1924x1556px, 200-degree field of view — 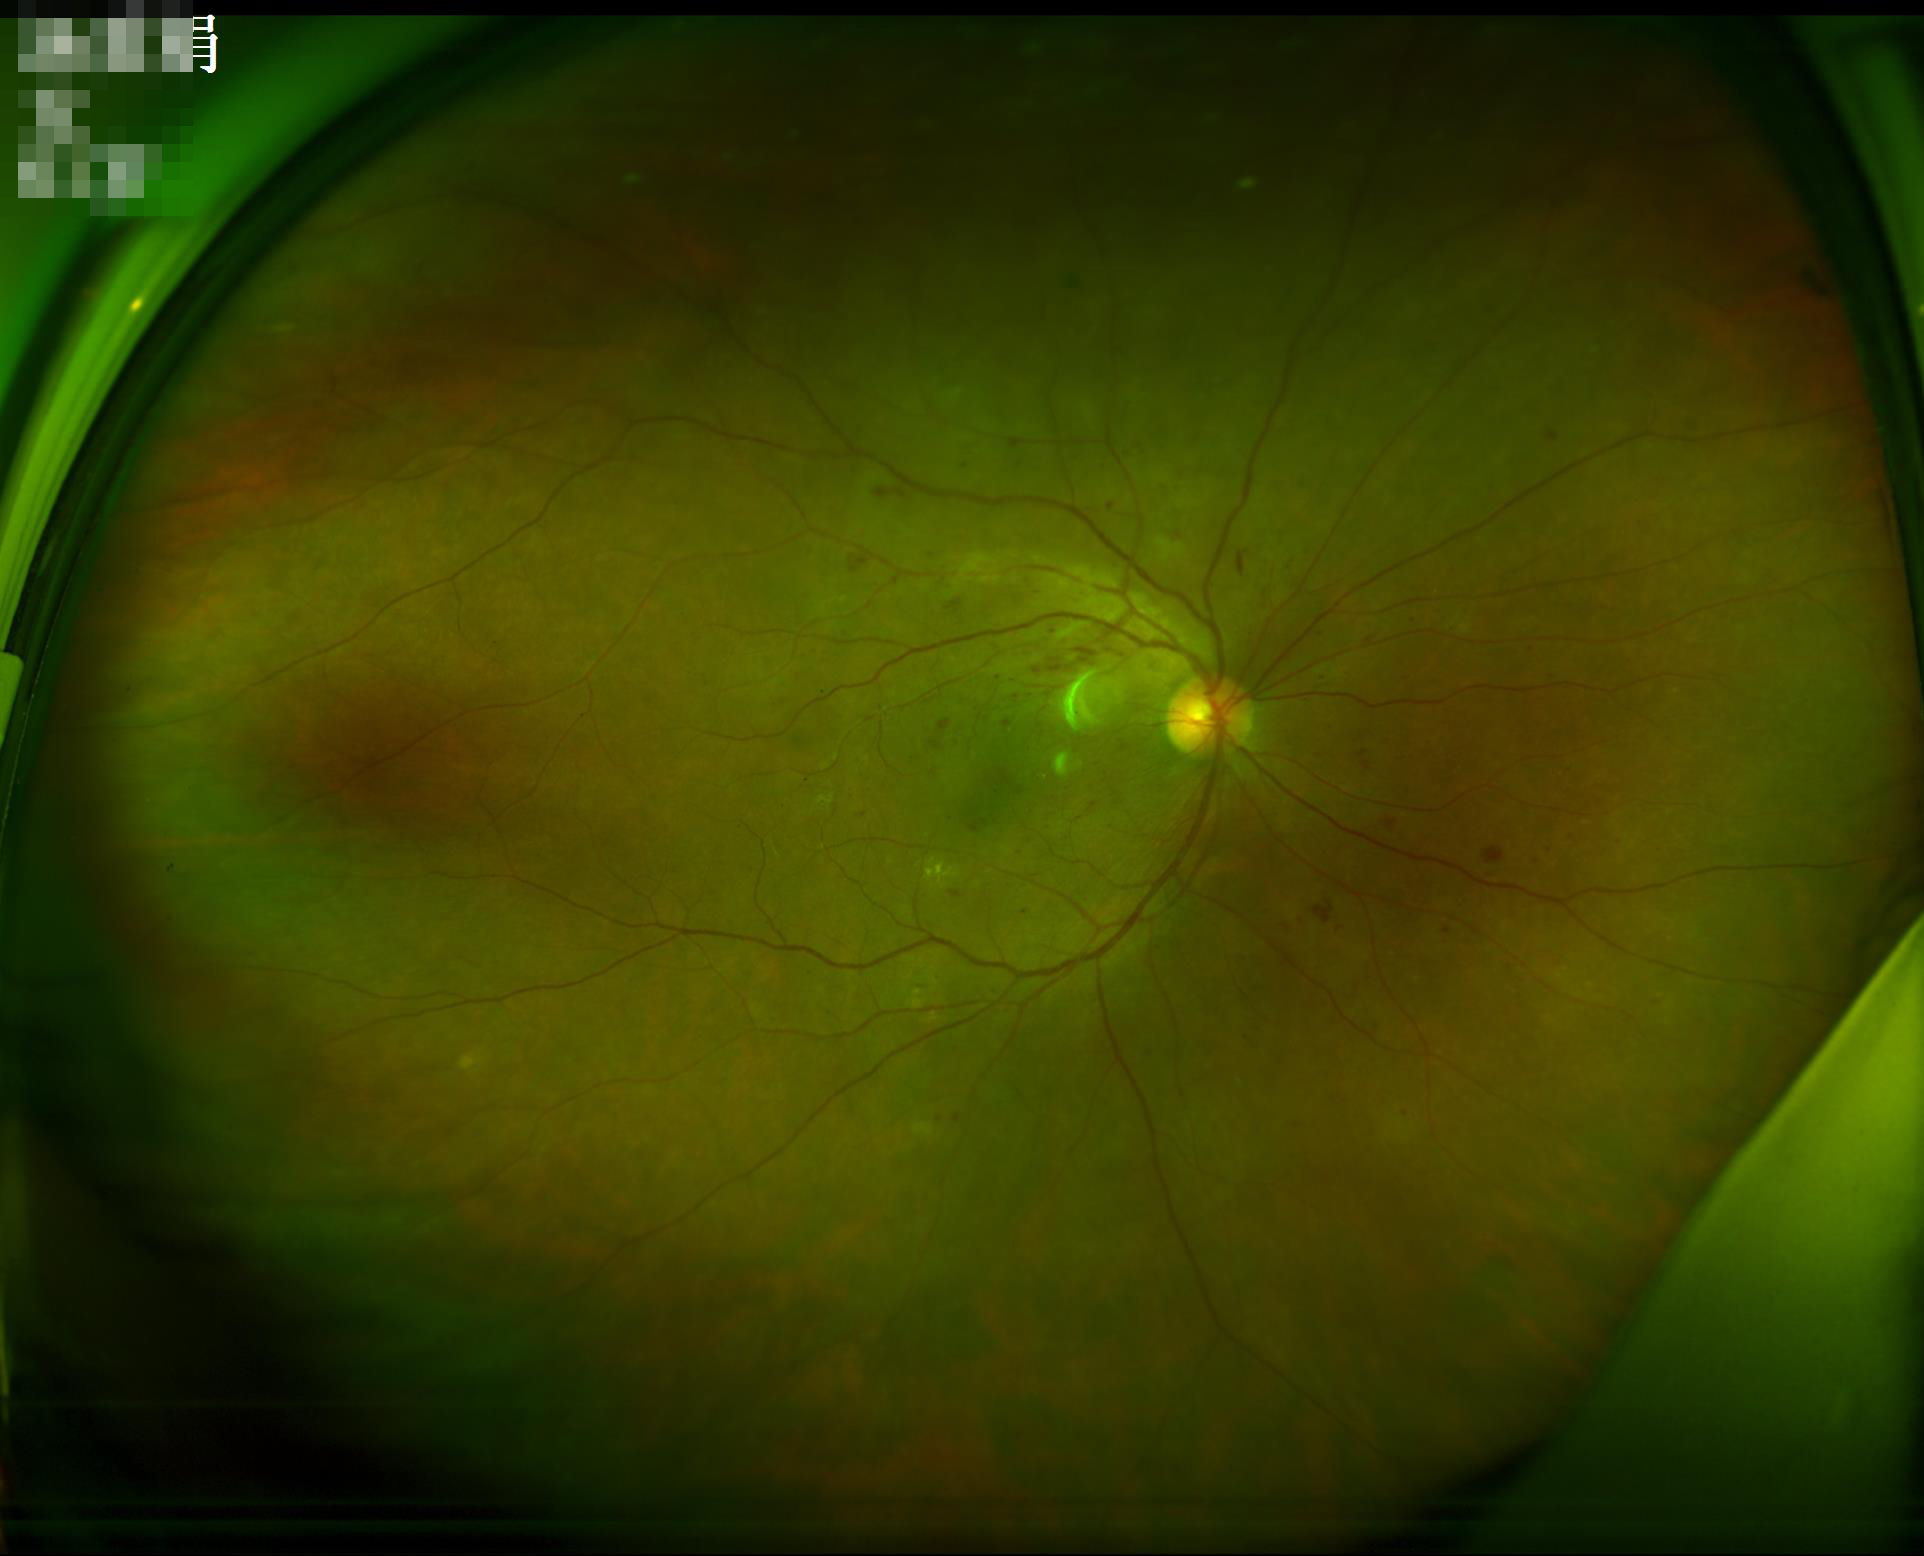
Image quality: contrast: vessels and details readily distinguishable; clarity: sharp throughout the field; overall: good and suitable for diagnostic use.